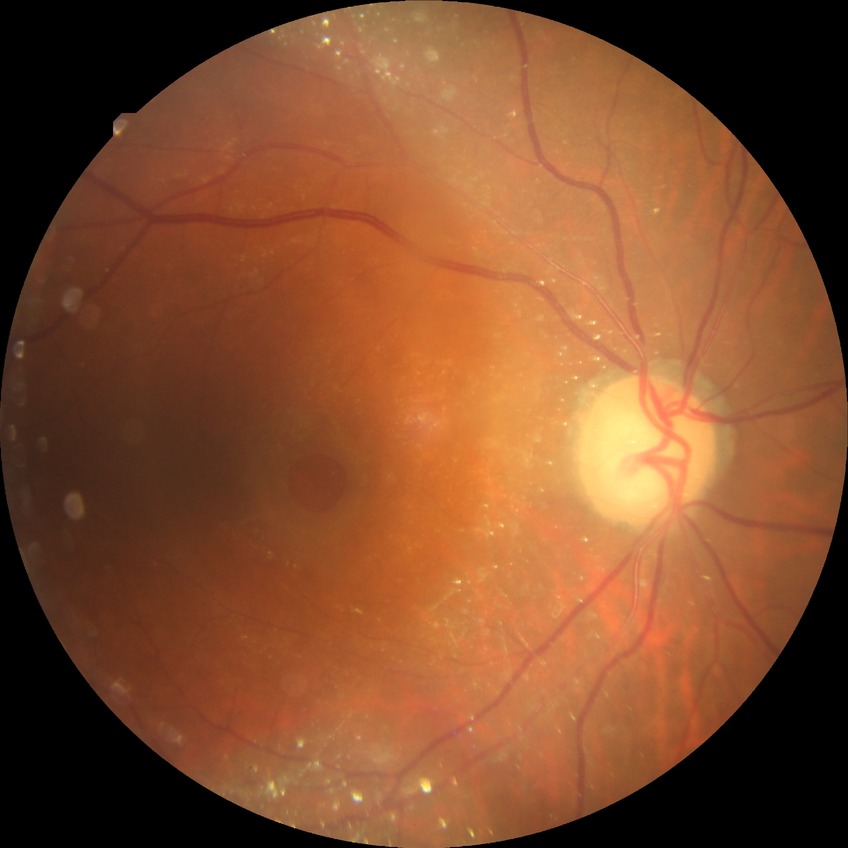 Annotations:
- modified Davis grading — no diabetic retinopathy